848 x 848 pixels; nonmydriatic — 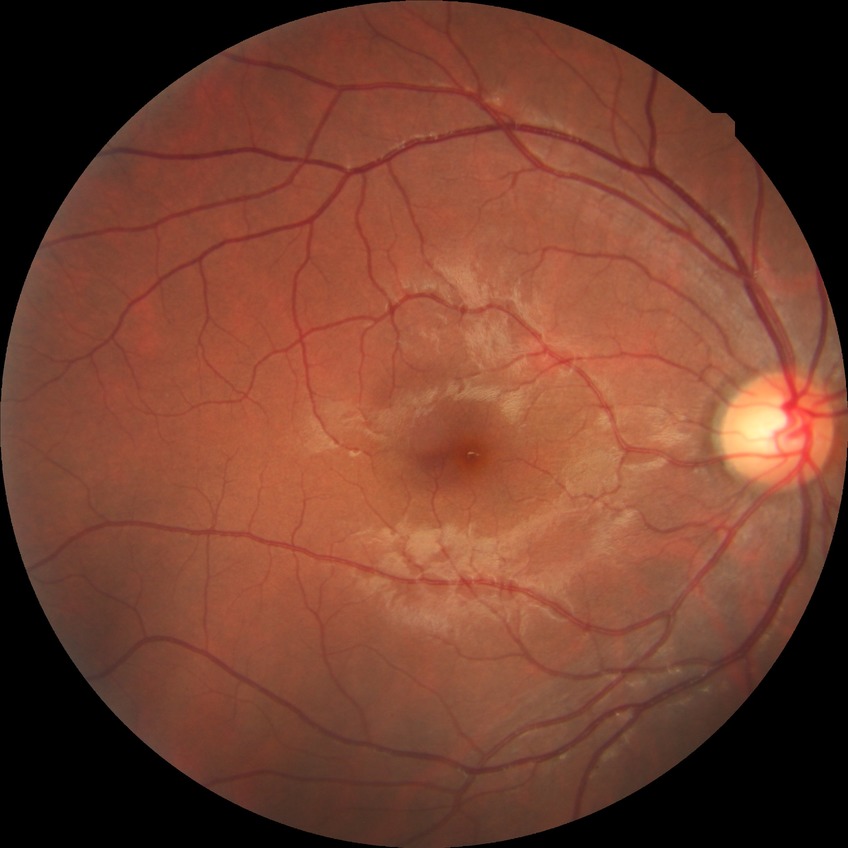 Davis stage: NDR